50° FOV; macula-centered.
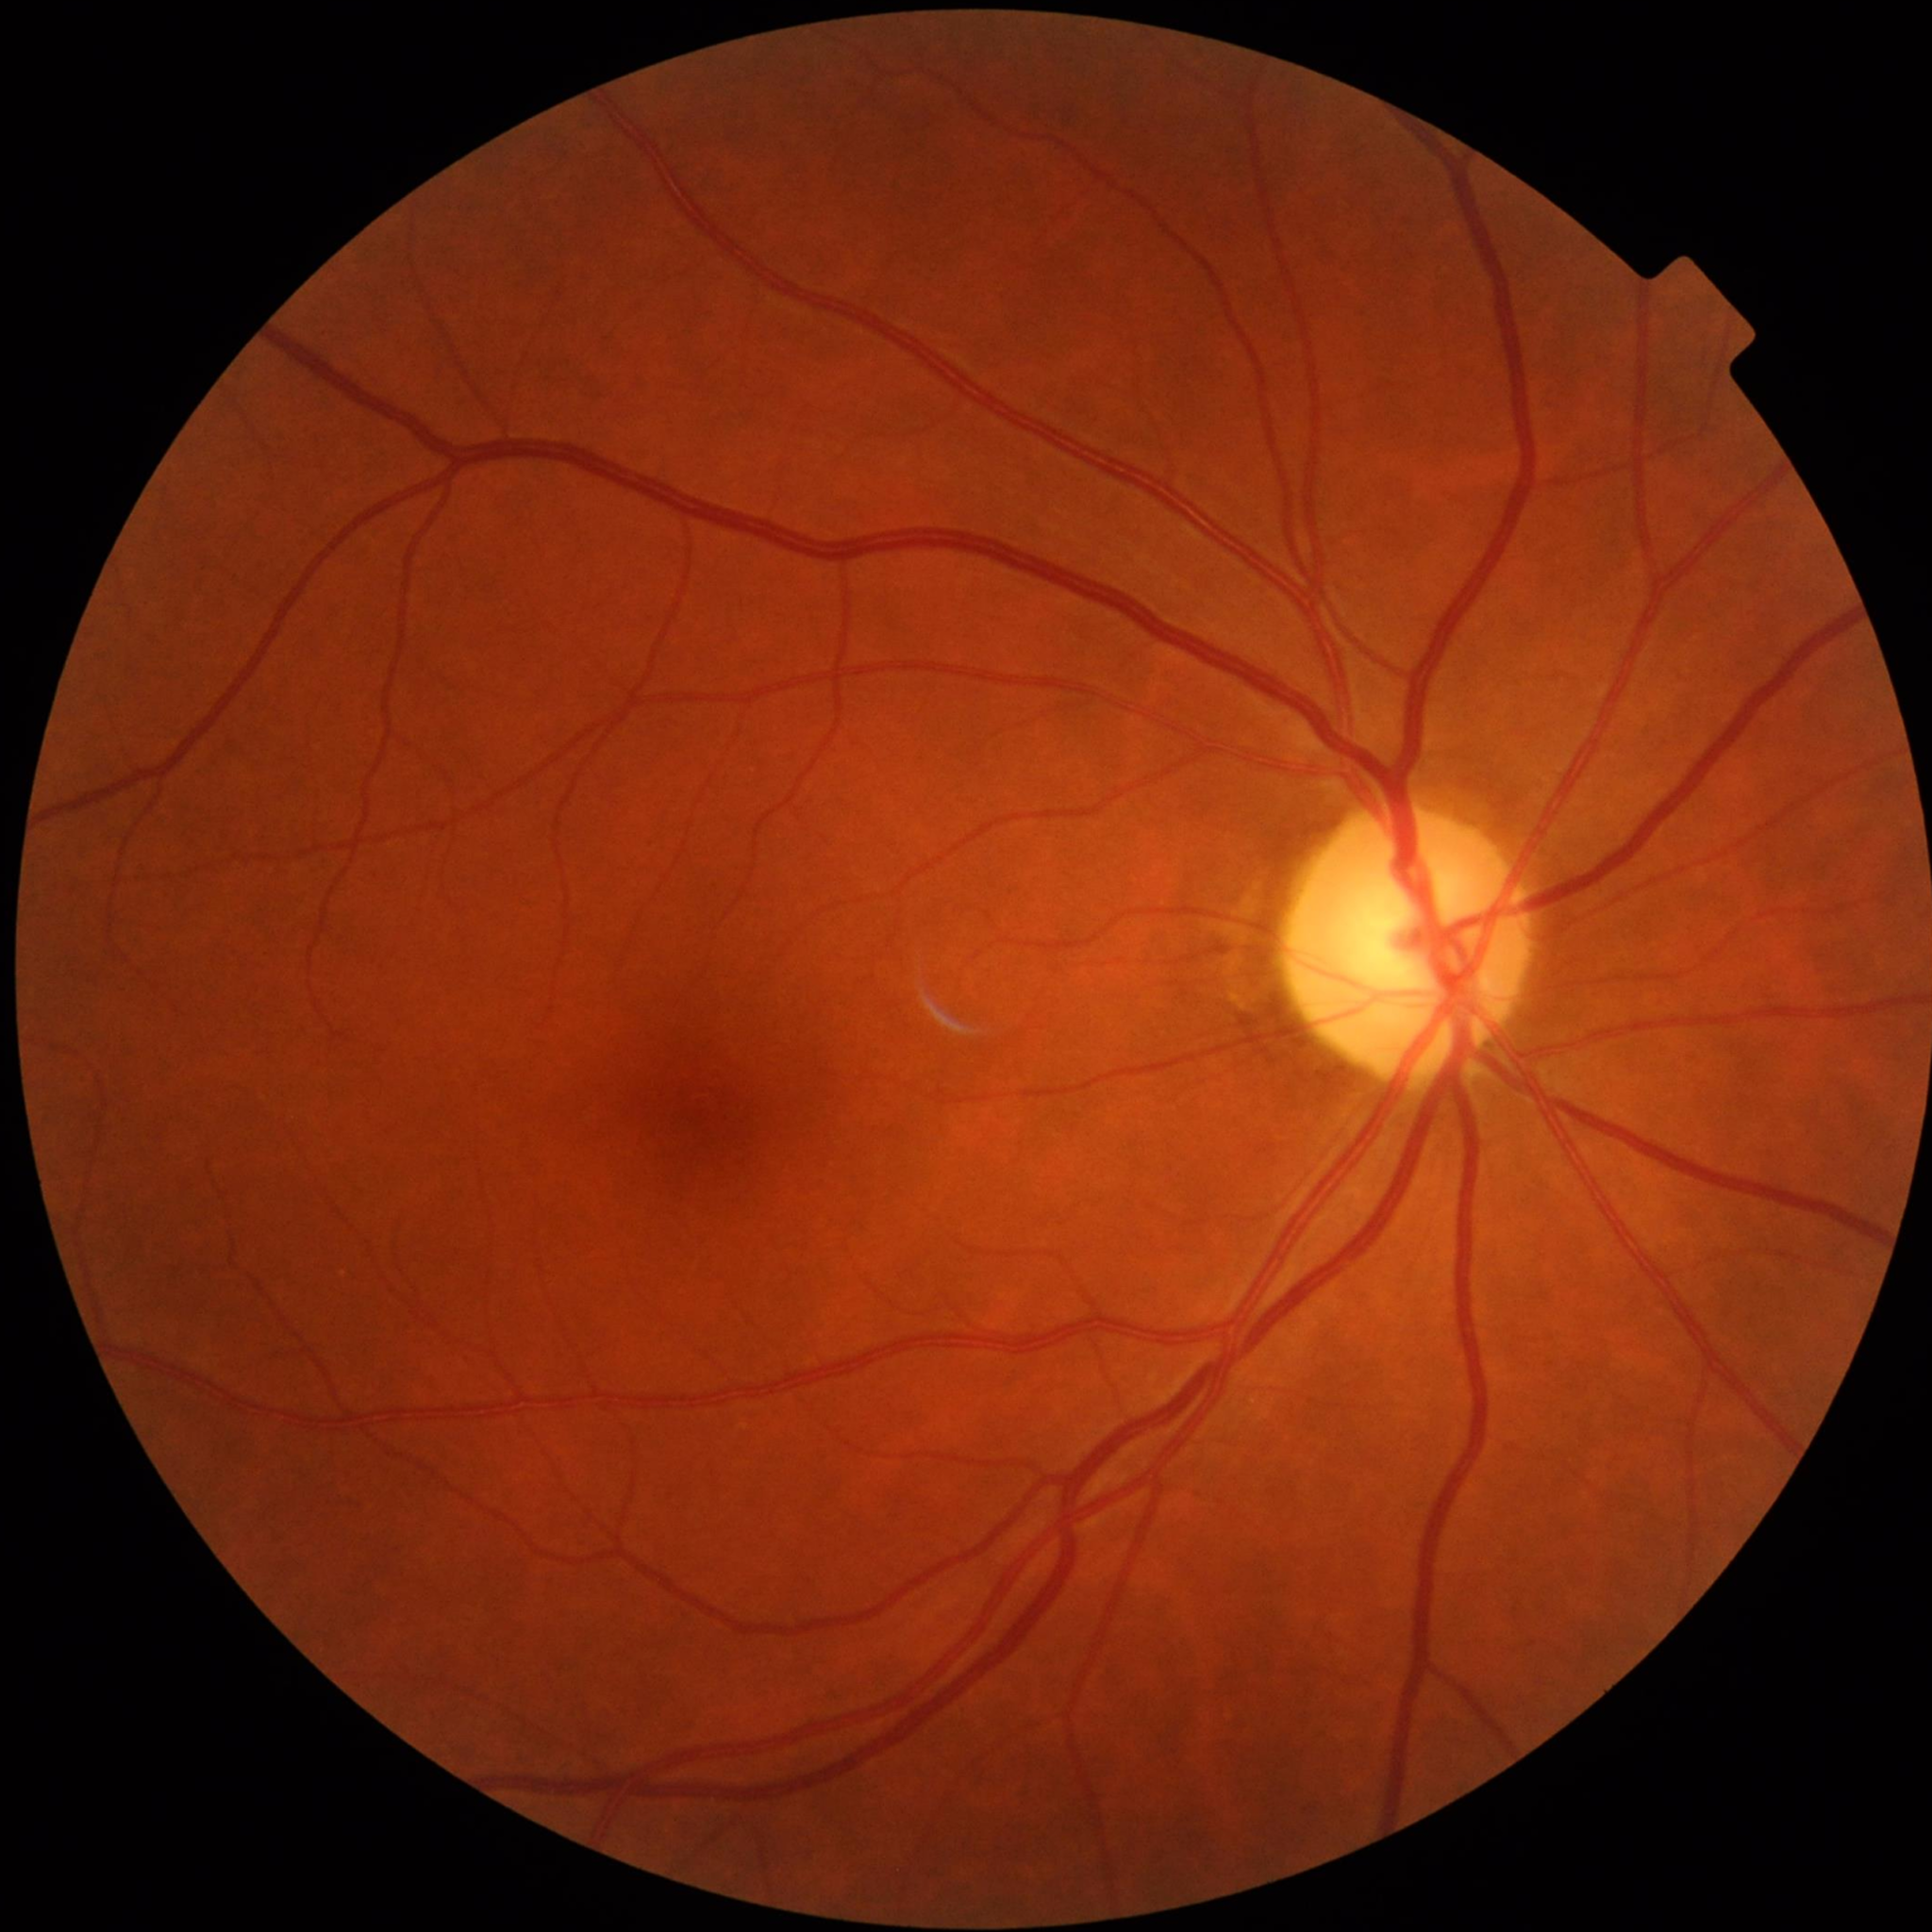

Disease: no AMD, DR, or glaucoma